Wide-field fundus photograph from neonatal ROP screening: 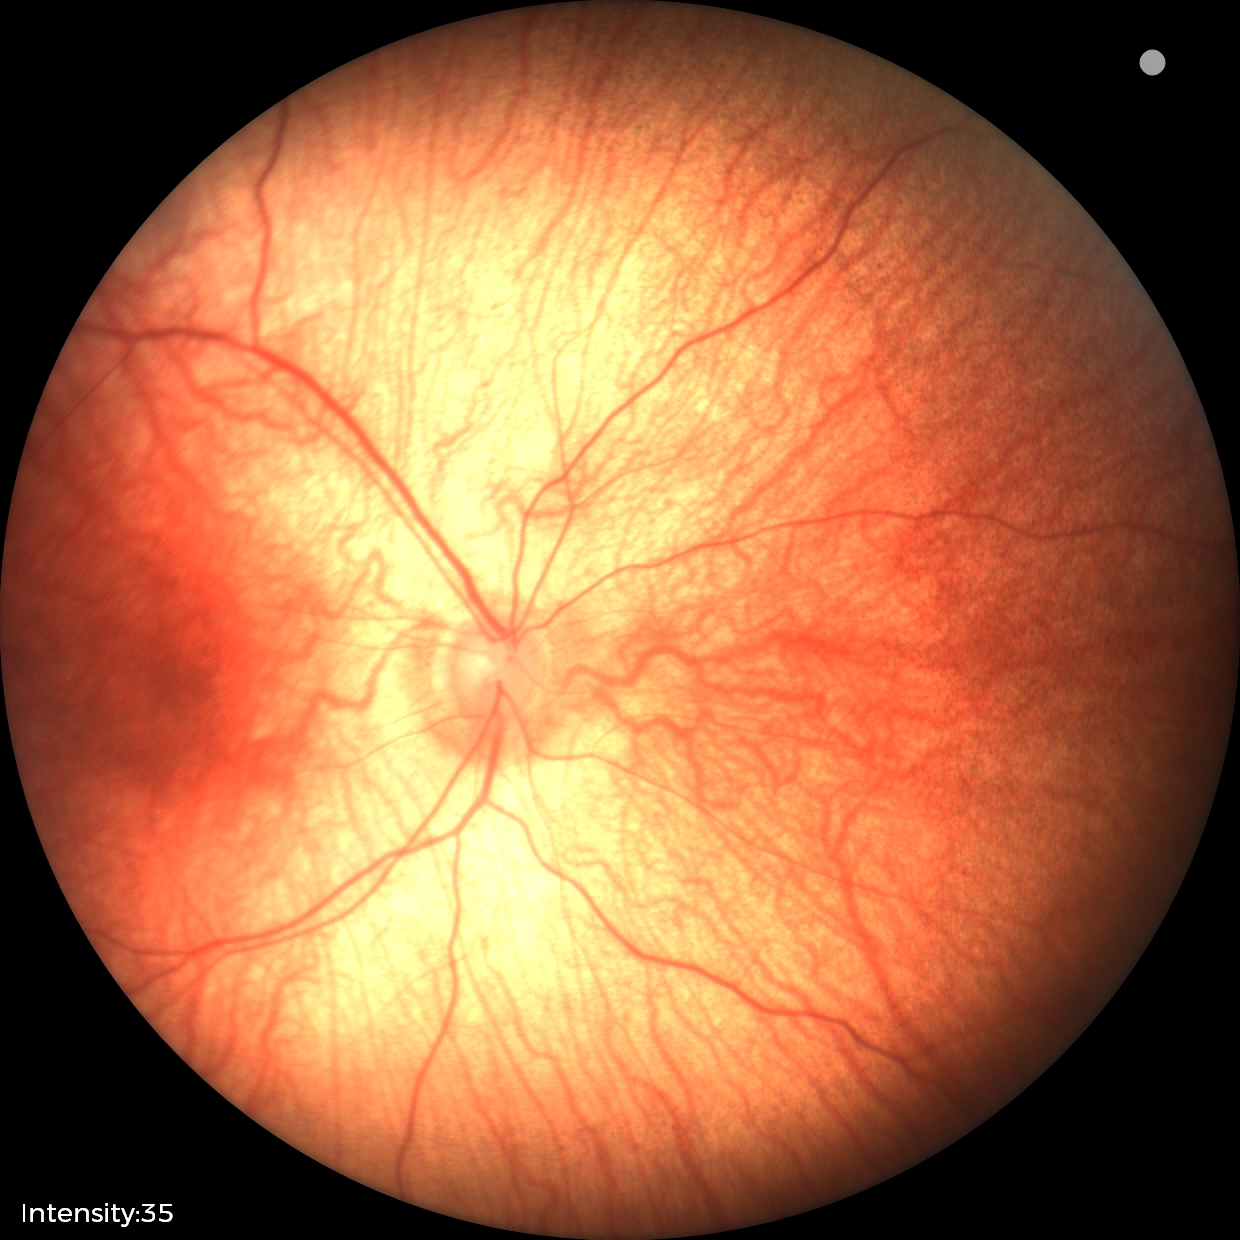
Assessment = no abnormalities.